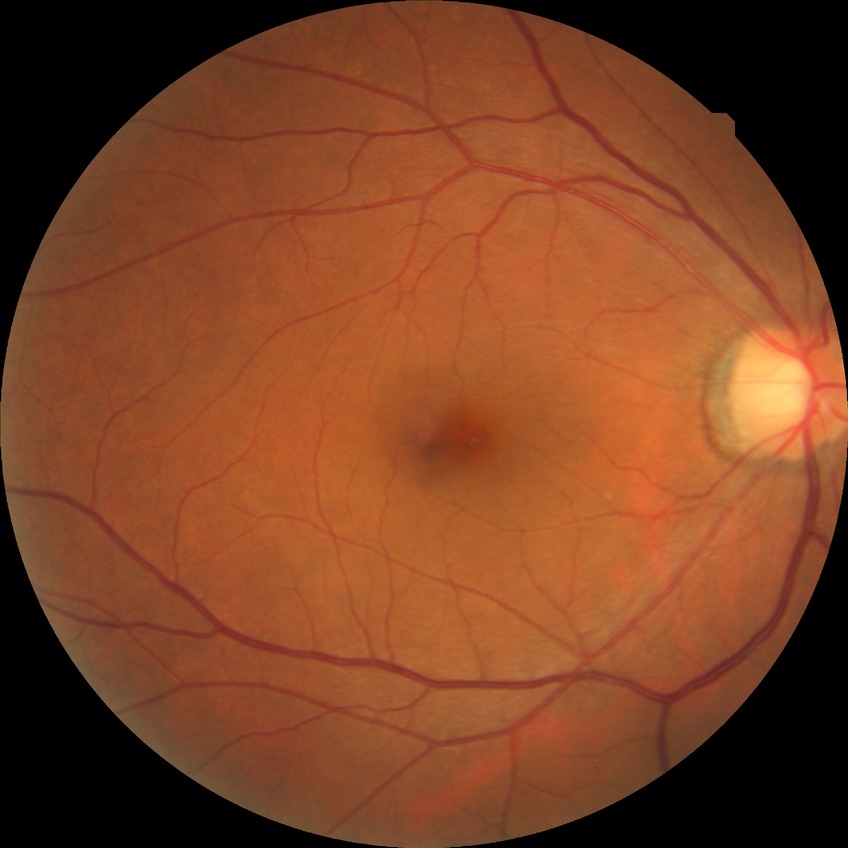

modified Davis grading: no diabetic retinopathy.